240 x 240 pixels — 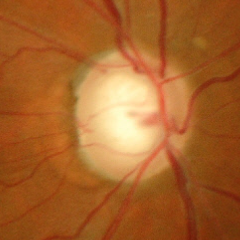
Glaucomatous optic neuropathy is present.
Advanced-stage glaucoma.
Diagnostic criteria: near-total cupping of the optic nerve head, with or without severe visual field loss within the central 10 degrees of fixation.